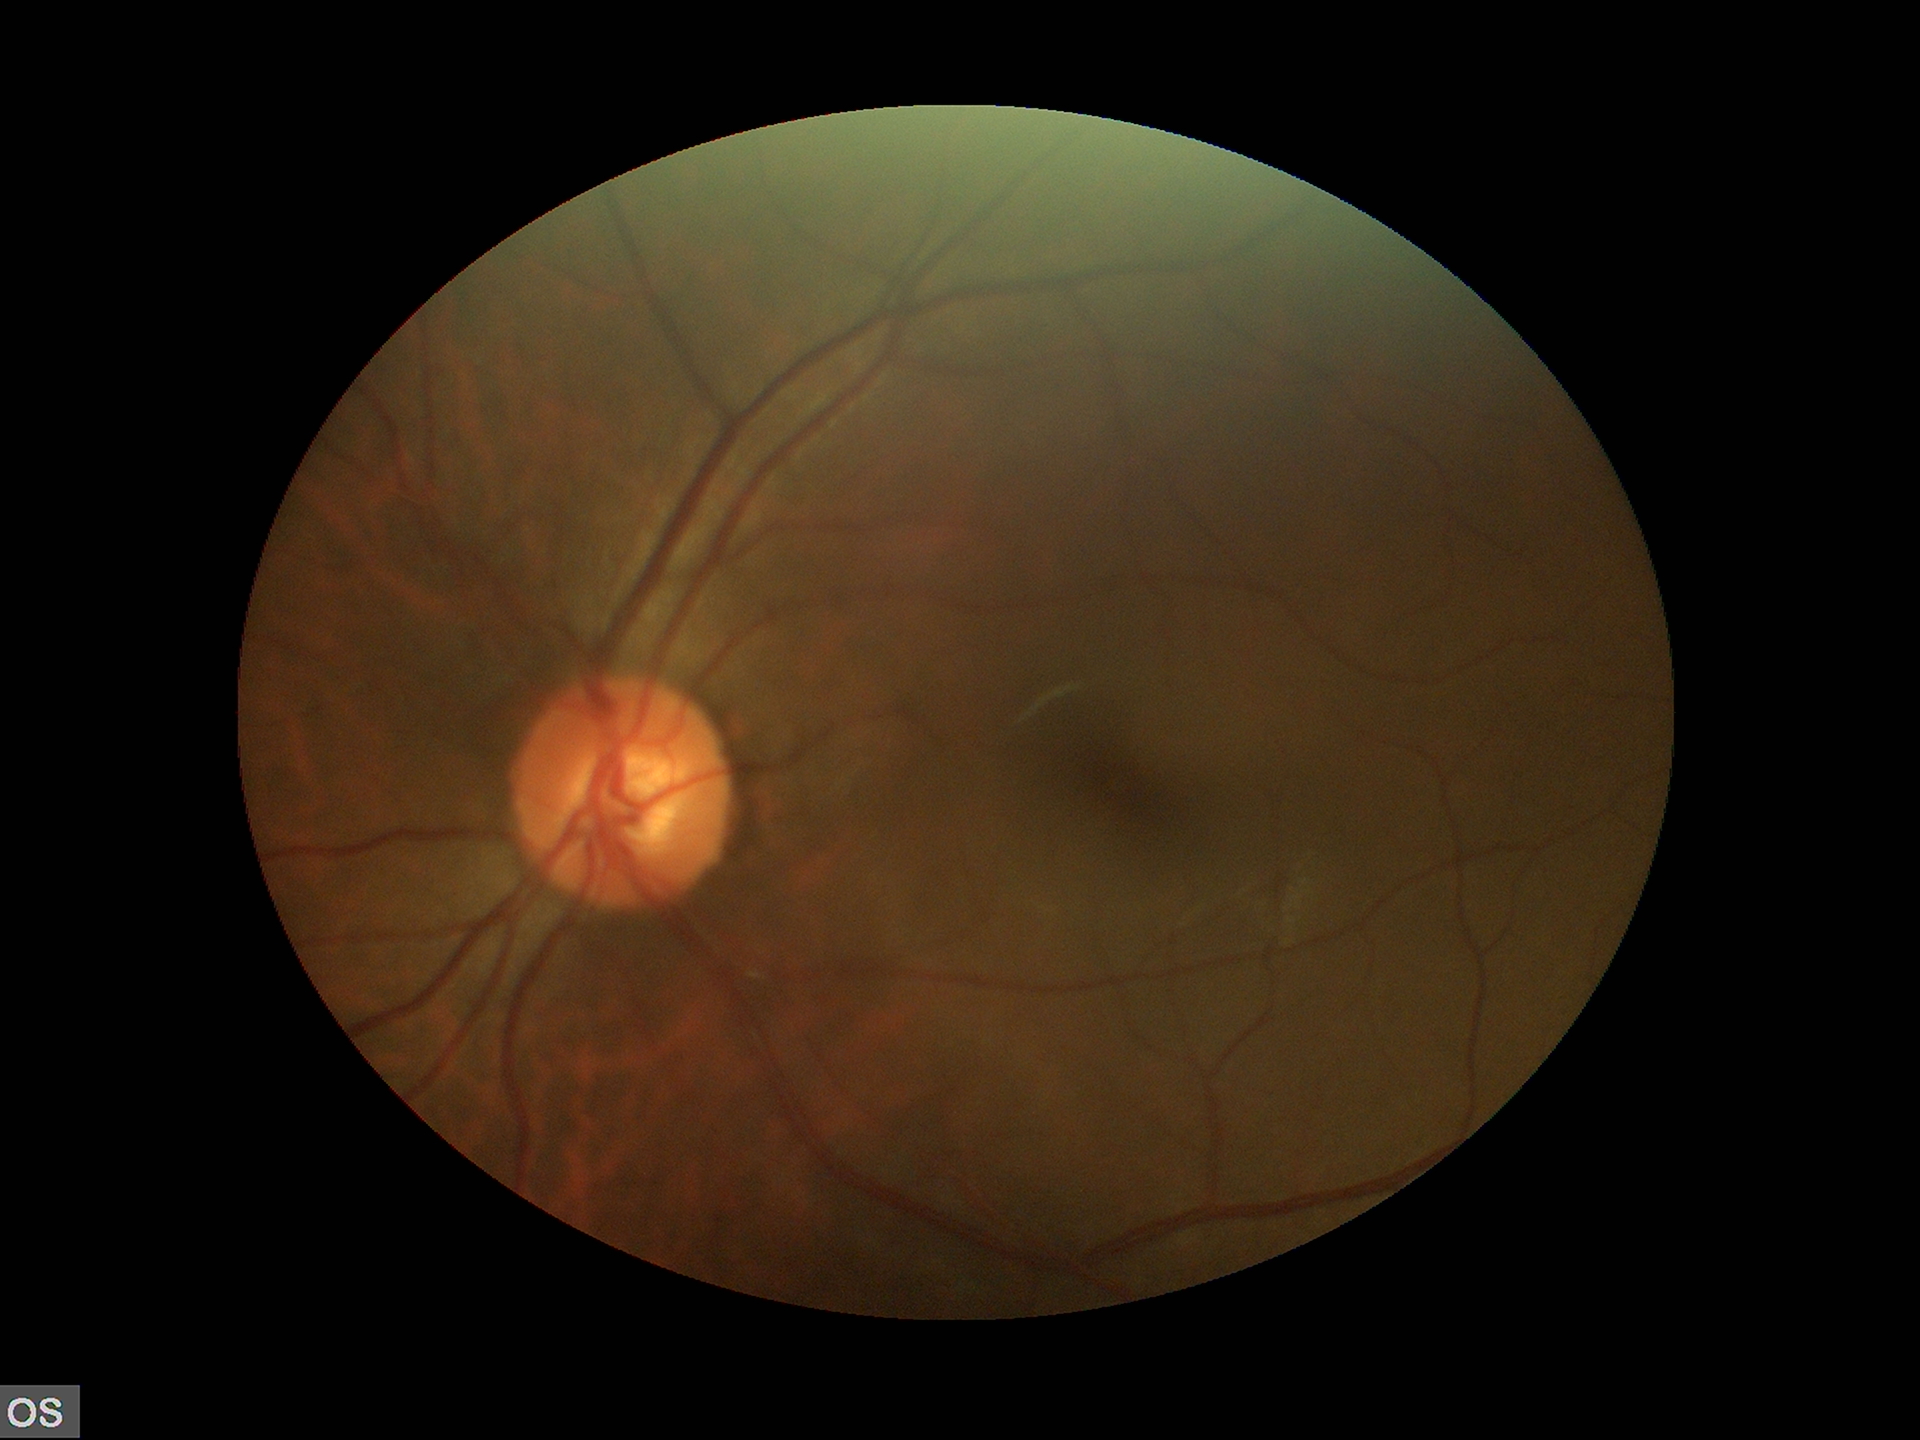 Findings:
* vertical C/D ratio (VCDR) · 0.48
* Glaucoma screening · no suspicious findings